45° field of view. 848 by 848 pixels:
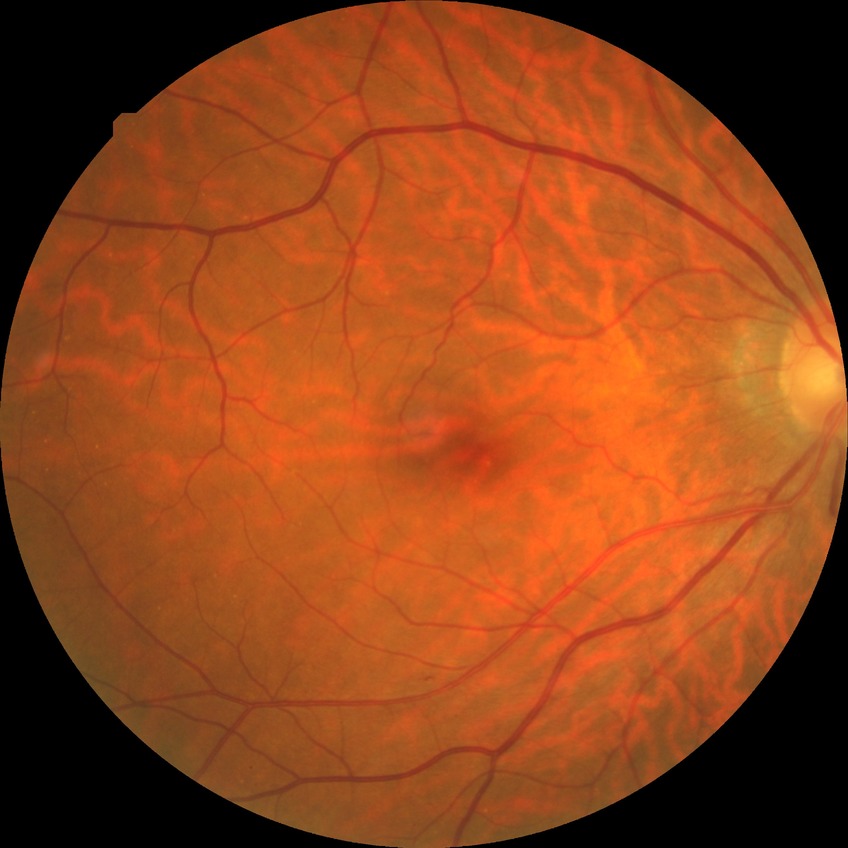
diabetic retinopathy (DR): SDR (simple diabetic retinopathy).